45-degree field of view: 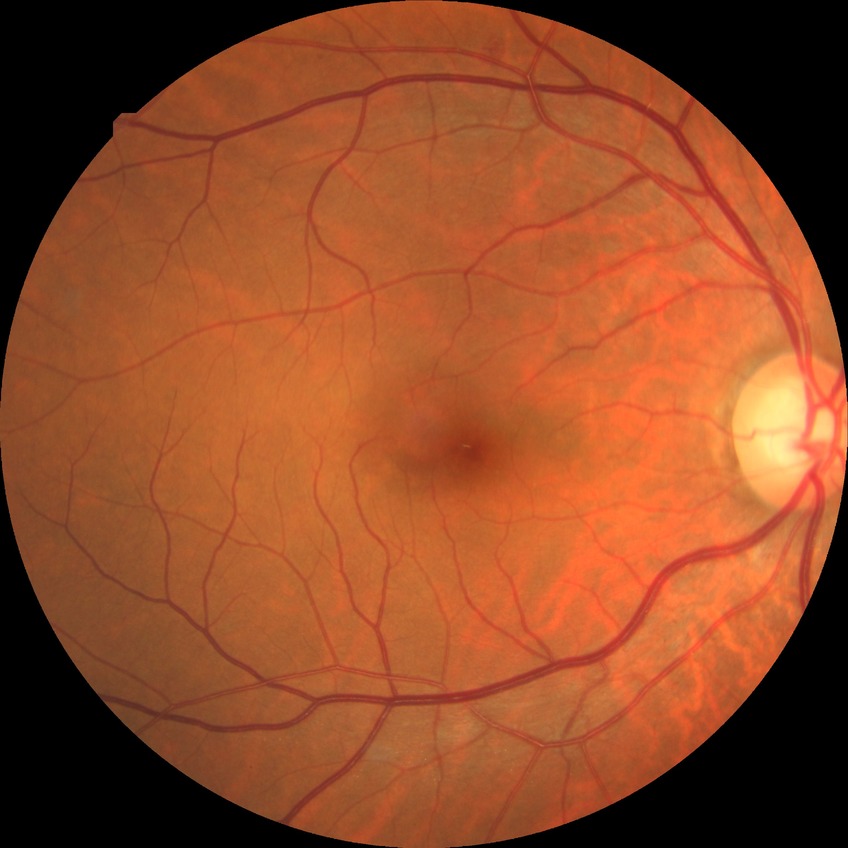

{"davis_grade": "no diabetic retinopathy (NDR)"}